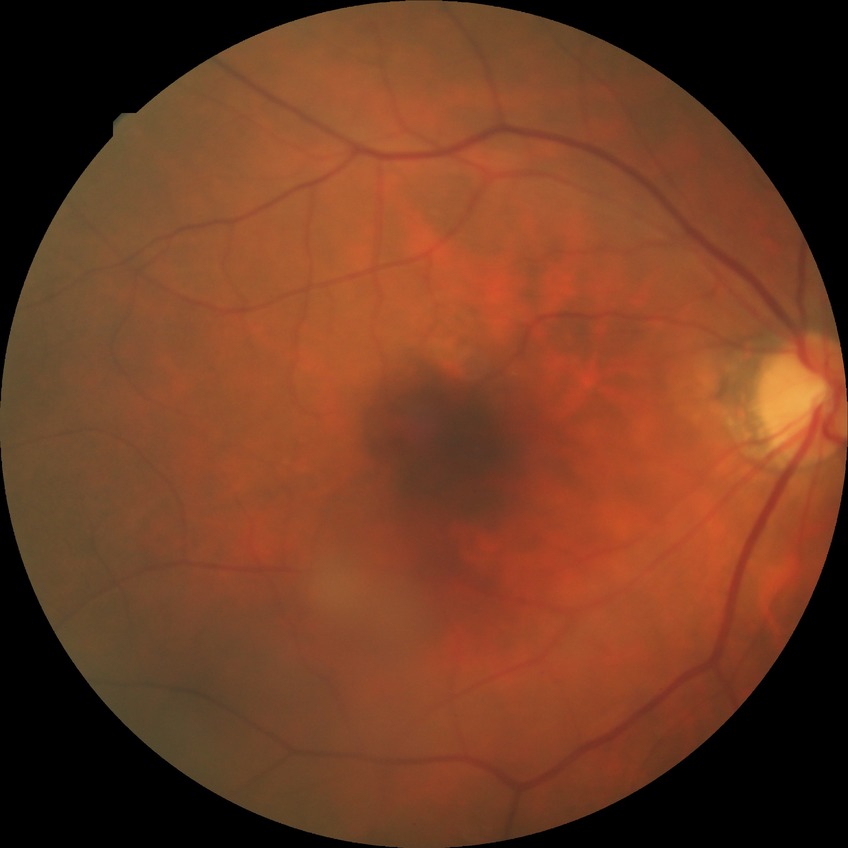

diabetic retinopathy (DR): NDR (no diabetic retinopathy).